Modified Davis grading; acquired with a NIDEK AFC-230
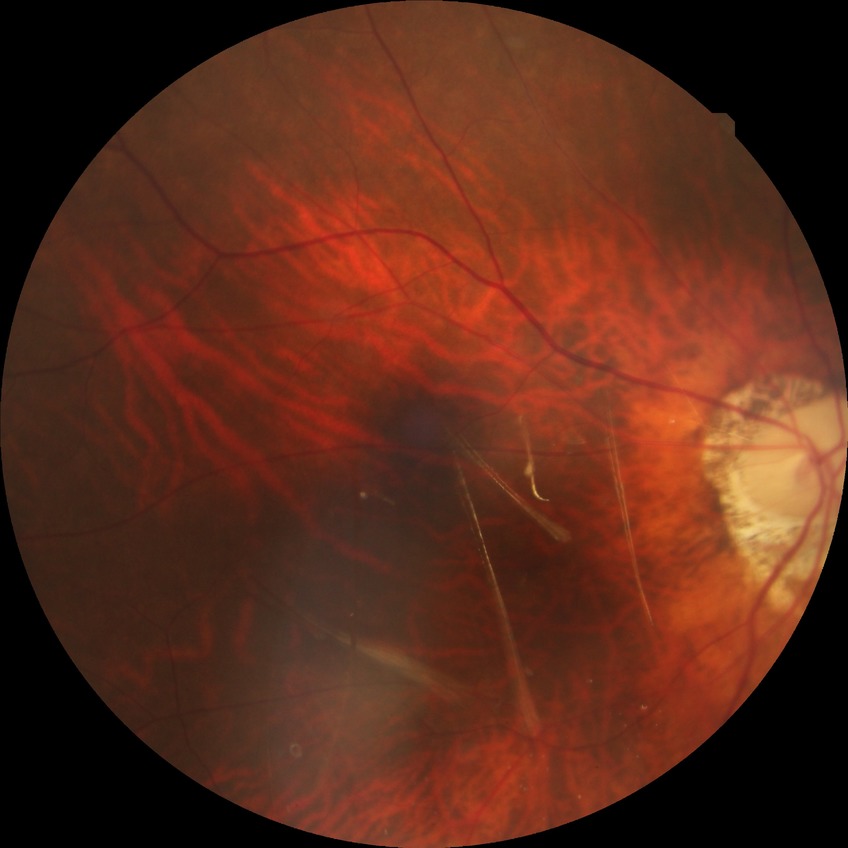

Diabetic retinopathy (DR) is NDR (no diabetic retinopathy).